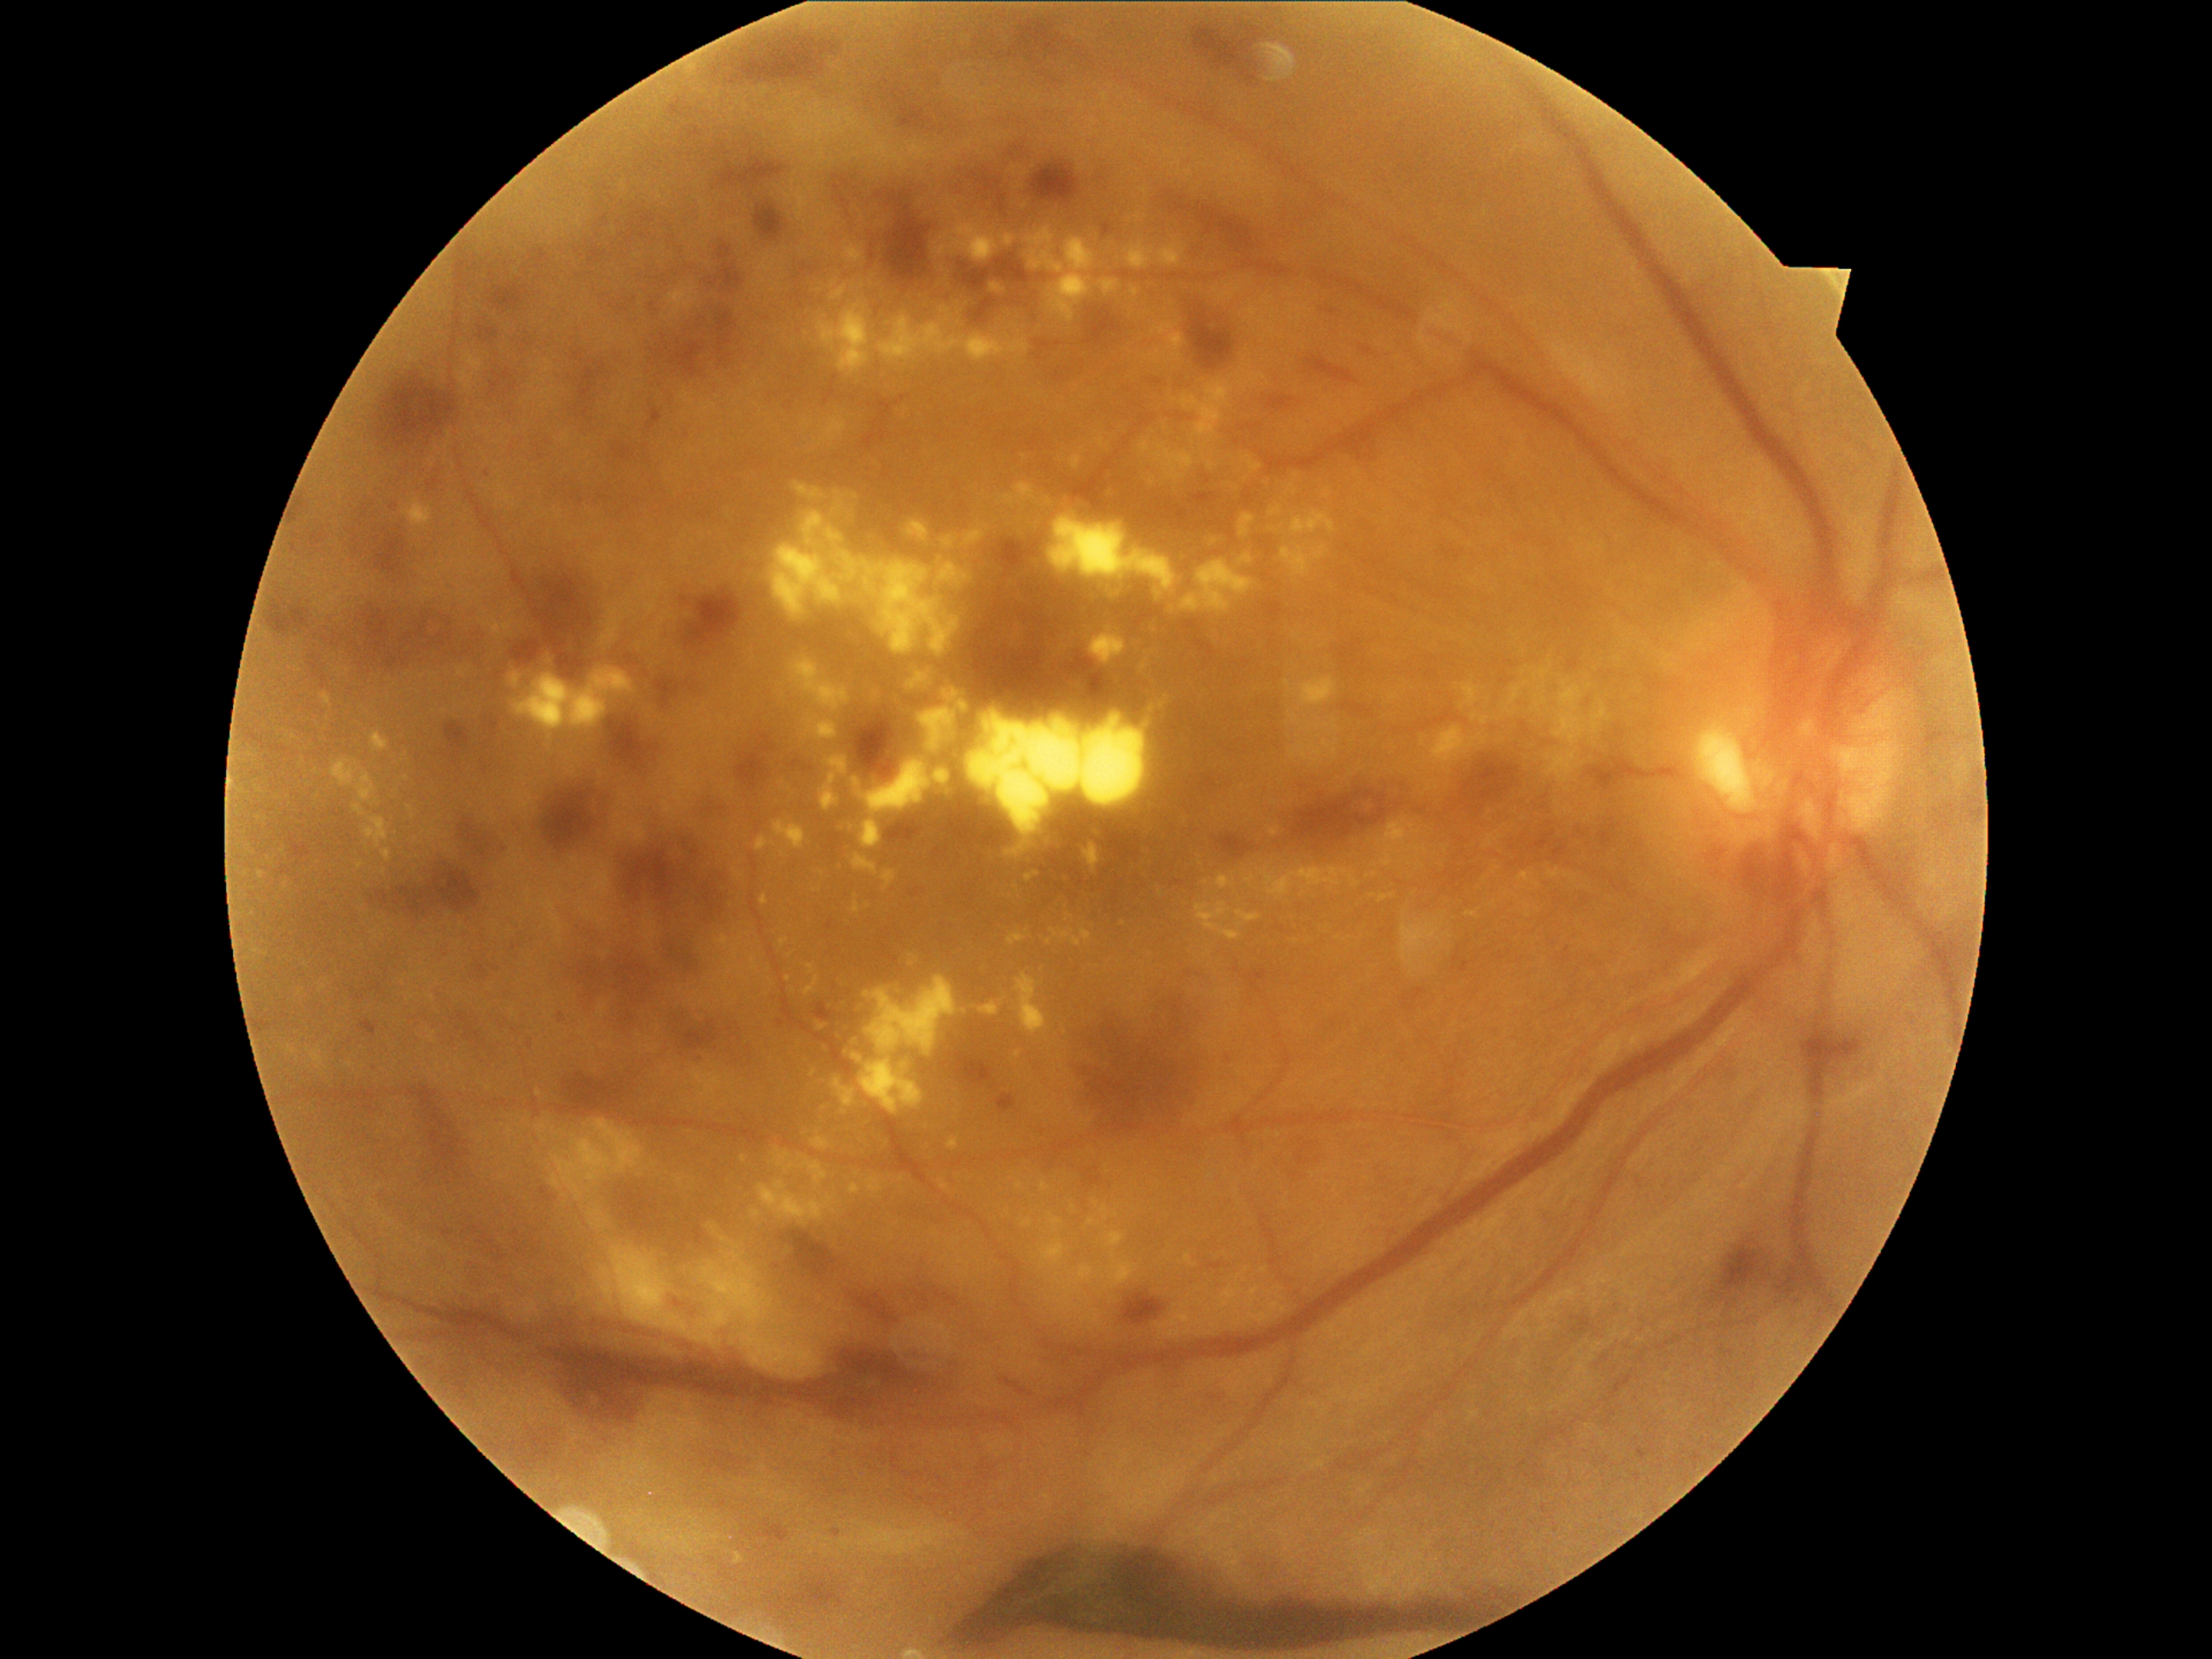 <lesions partial="true">
  <dr_grade>4</dr_grade>
  <ma partial="true">(left=1240, top=970, right=1267, bottom=994); (left=998, top=1095, right=1016, bottom=1114); (left=492, top=721, right=499, bottom=736); (left=1182, top=620, right=1199, bottom=632); (left=902, top=108, right=924, bottom=127); (left=489, top=282, right=523, bottom=311); (left=871, top=245, right=876, bottom=260); (left=1402, top=989, right=1426, bottom=1011); (left=835, top=194, right=853, bottom=209); (left=762, top=1520, right=789, bottom=1542); (left=999, top=190, right=1006, bottom=212); (left=559, top=1013, right=566, bottom=1023); (left=1037, top=341, right=1052, bottom=361)</ma>
  <ma_small_approx>780:1023; 488:475; 849:215</ma_small_approx>
  <ex partial="true">(left=1472, top=713, right=1479, bottom=723); (left=1105, top=1231, right=1126, bottom=1249); (left=752, top=1209, right=760, bottom=1220); (left=1047, top=515, right=1179, bottom=600); (left=1510, top=687, right=1522, bottom=706); (left=1271, top=506, right=1283, bottom=516); (left=1090, top=627, right=1127, bottom=665); (left=1083, top=844, right=1100, bottom=875); (left=1532, top=694, right=1547, bottom=713); (left=1378, top=820, right=1428, bottom=868); (left=1081, top=929, right=1091, bottom=945); (left=801, top=1160, right=829, bottom=1190)</ex>
  <ex_small_approx>888:323; 1416:832; 1145:666; 360:865; 826:318; 1285:1310; 1330:734; 1060:651</ex_small_approx>
</lesions>